Pupil-dilated. Camera: Topcon TRC-50DX. Central posterior field — 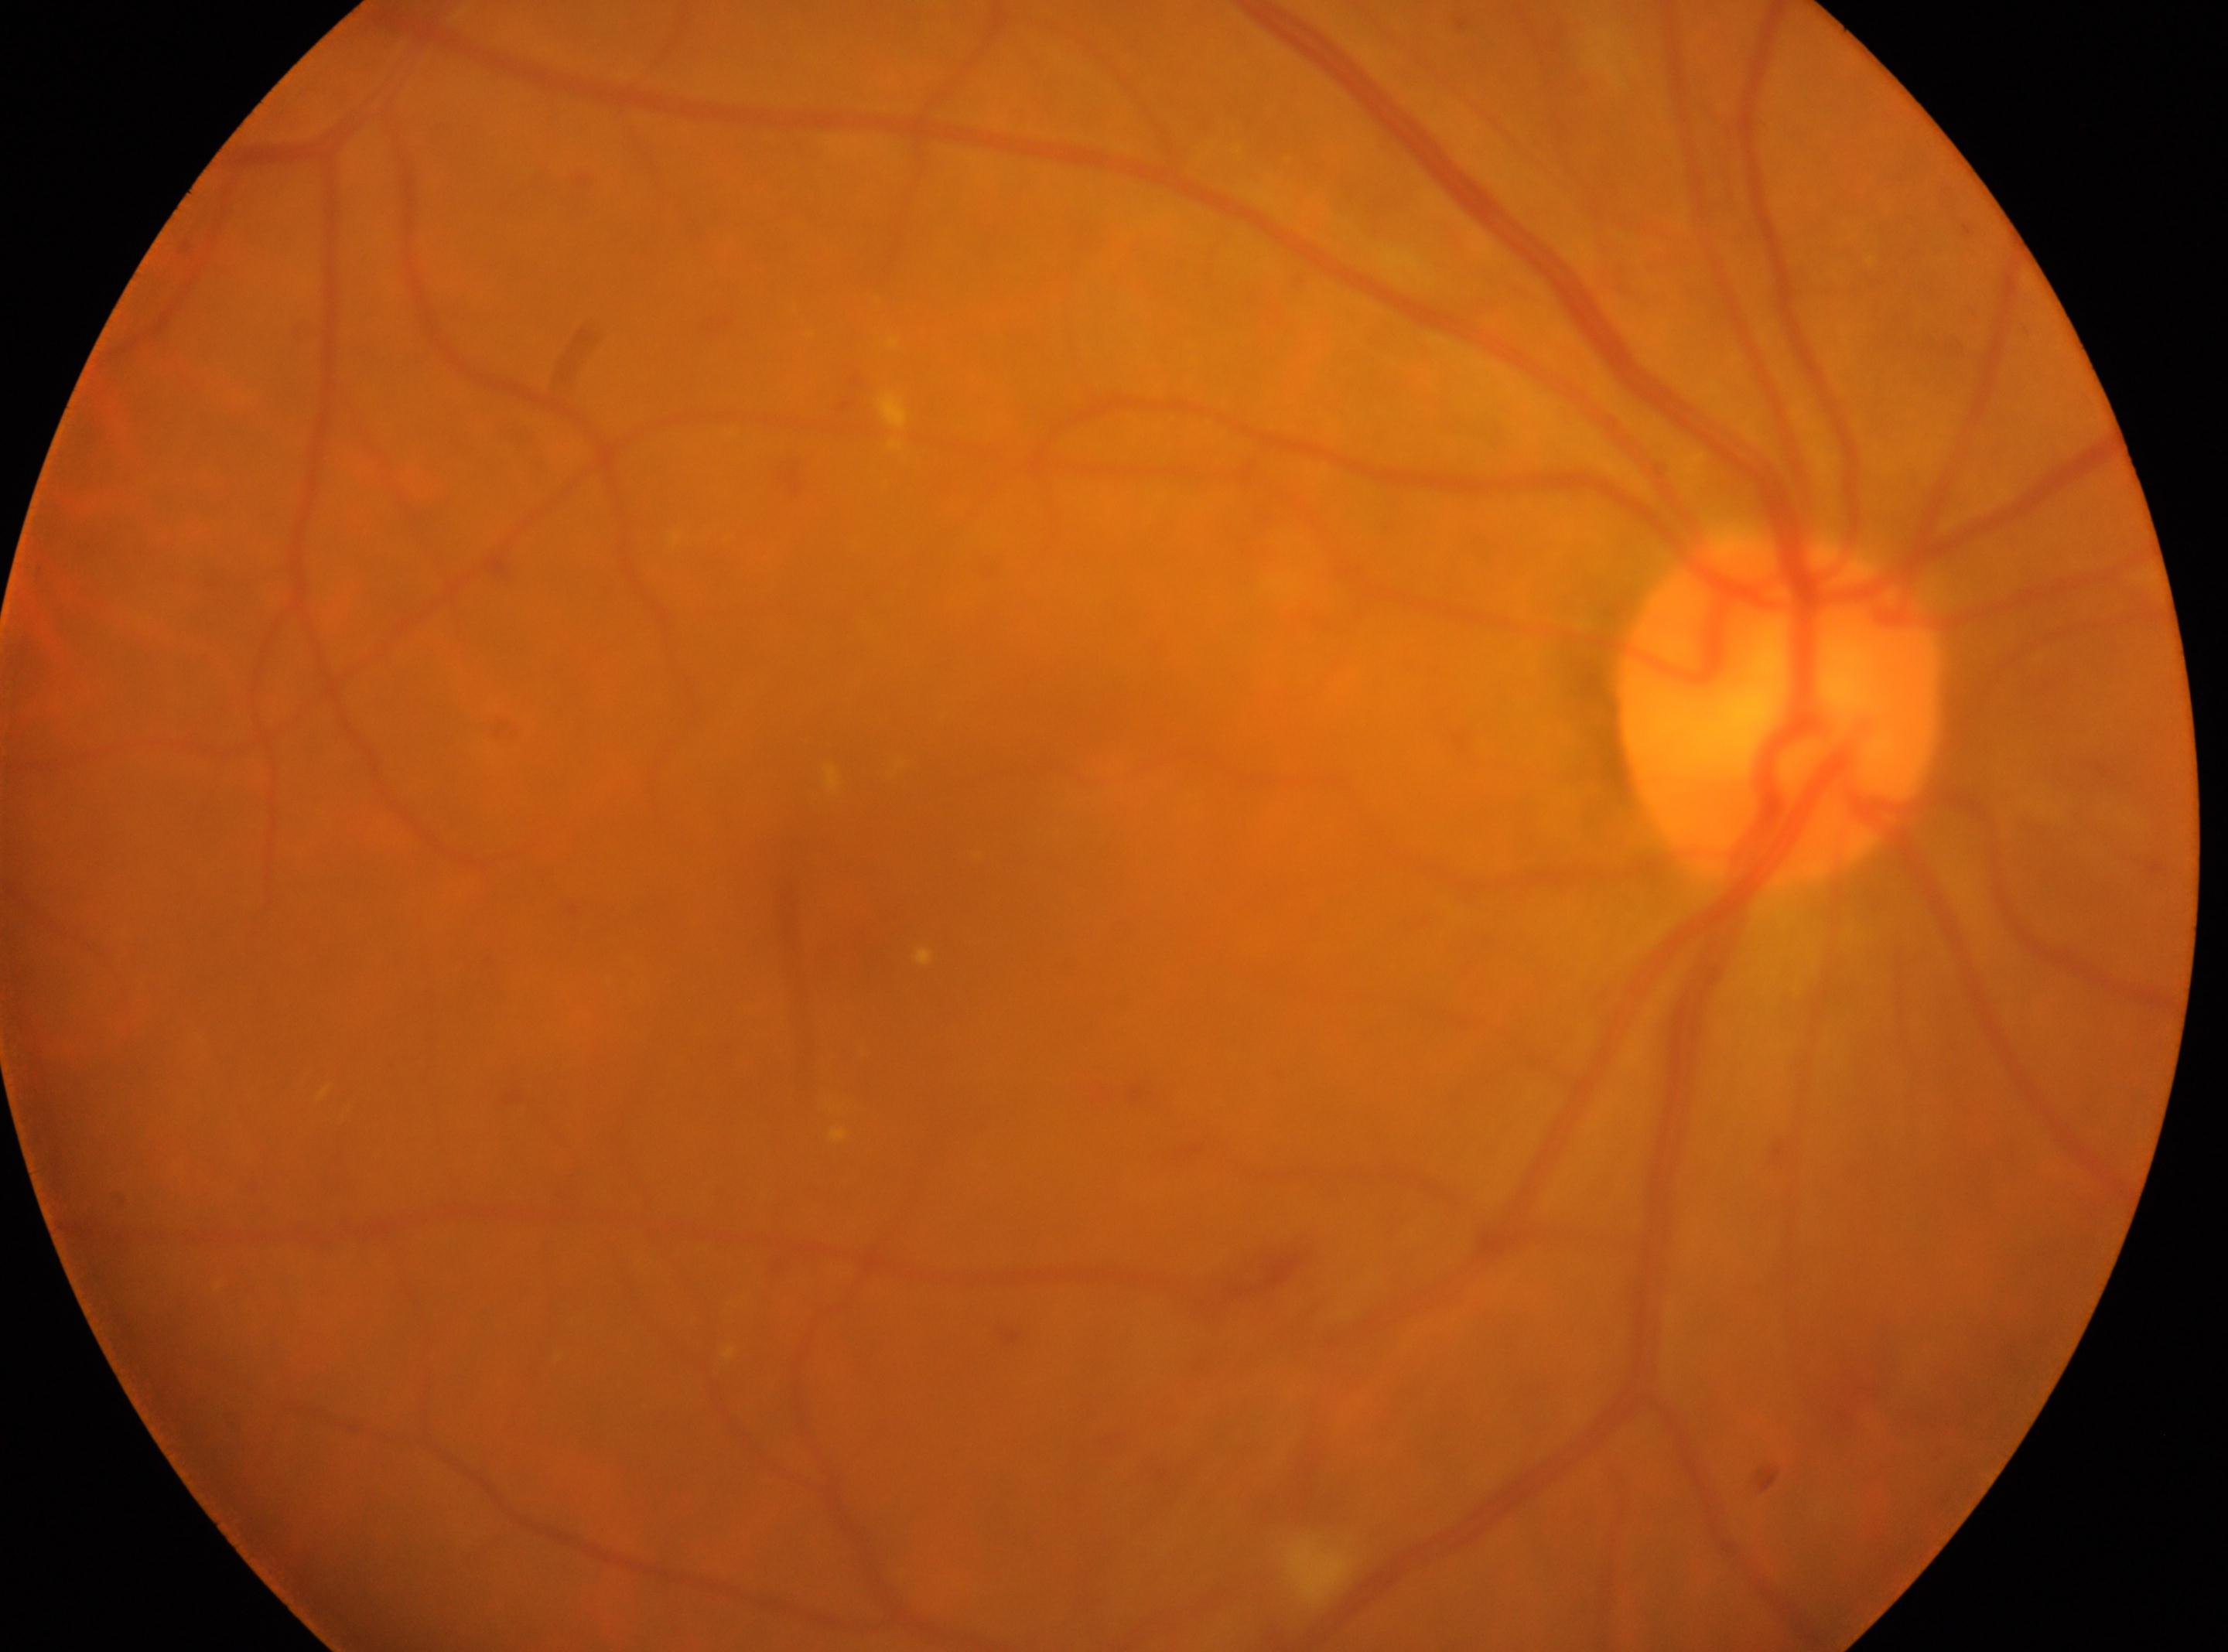 Optic disc located at 1779px, 709px. Imaged eye: right. Diabetic retinopathy (DR) is 2. Fovea: 856px, 906px.